640 x 480 pixels · pediatric retinal photograph (wide-field) · camera: Clarity RetCam 3 (130° FOV) — 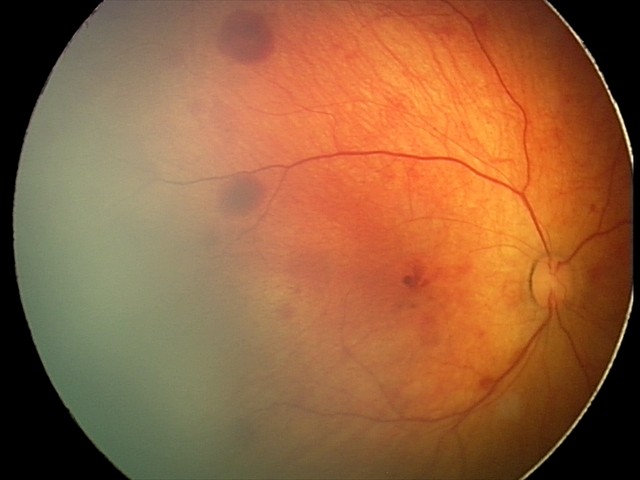

Screening examination consistent with retinal hemorrhages.